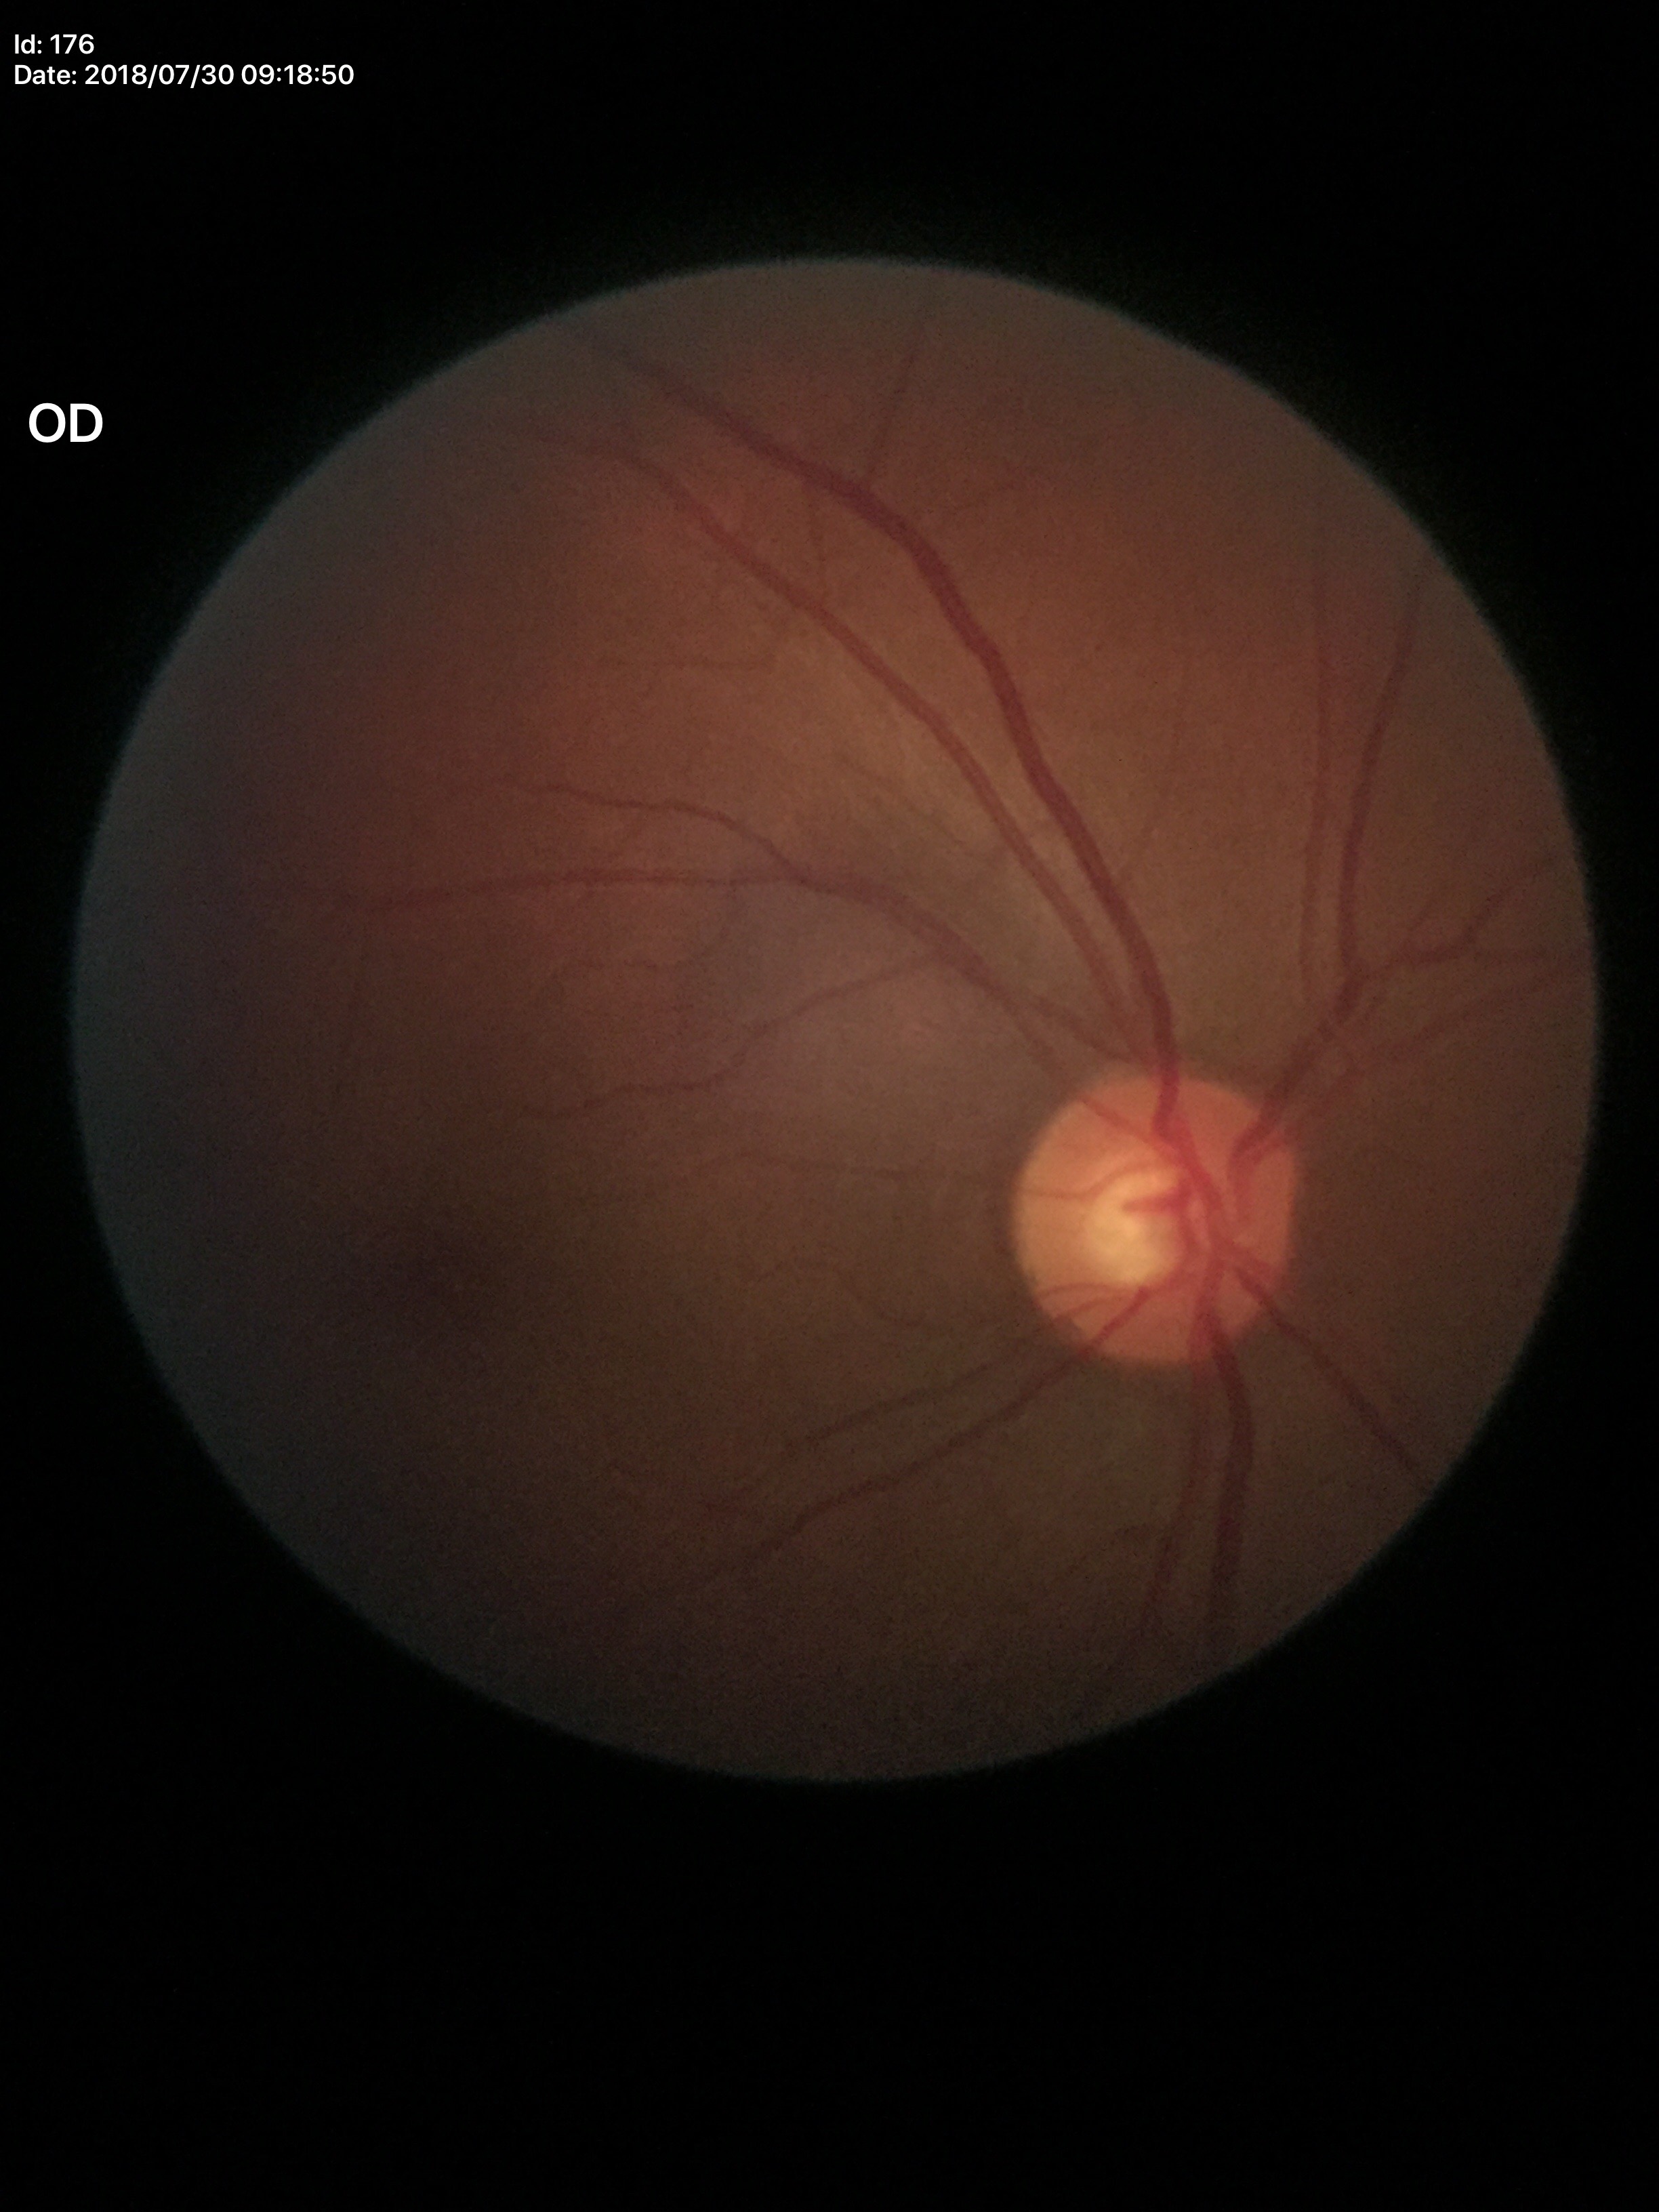
Negative for glaucoma suspicion (5/5 ophthalmologists in agreement). Horizontal CDR is 0.52. Vertical CDR: 0.51.